Mydriatic (tropicamide 0.5%) — 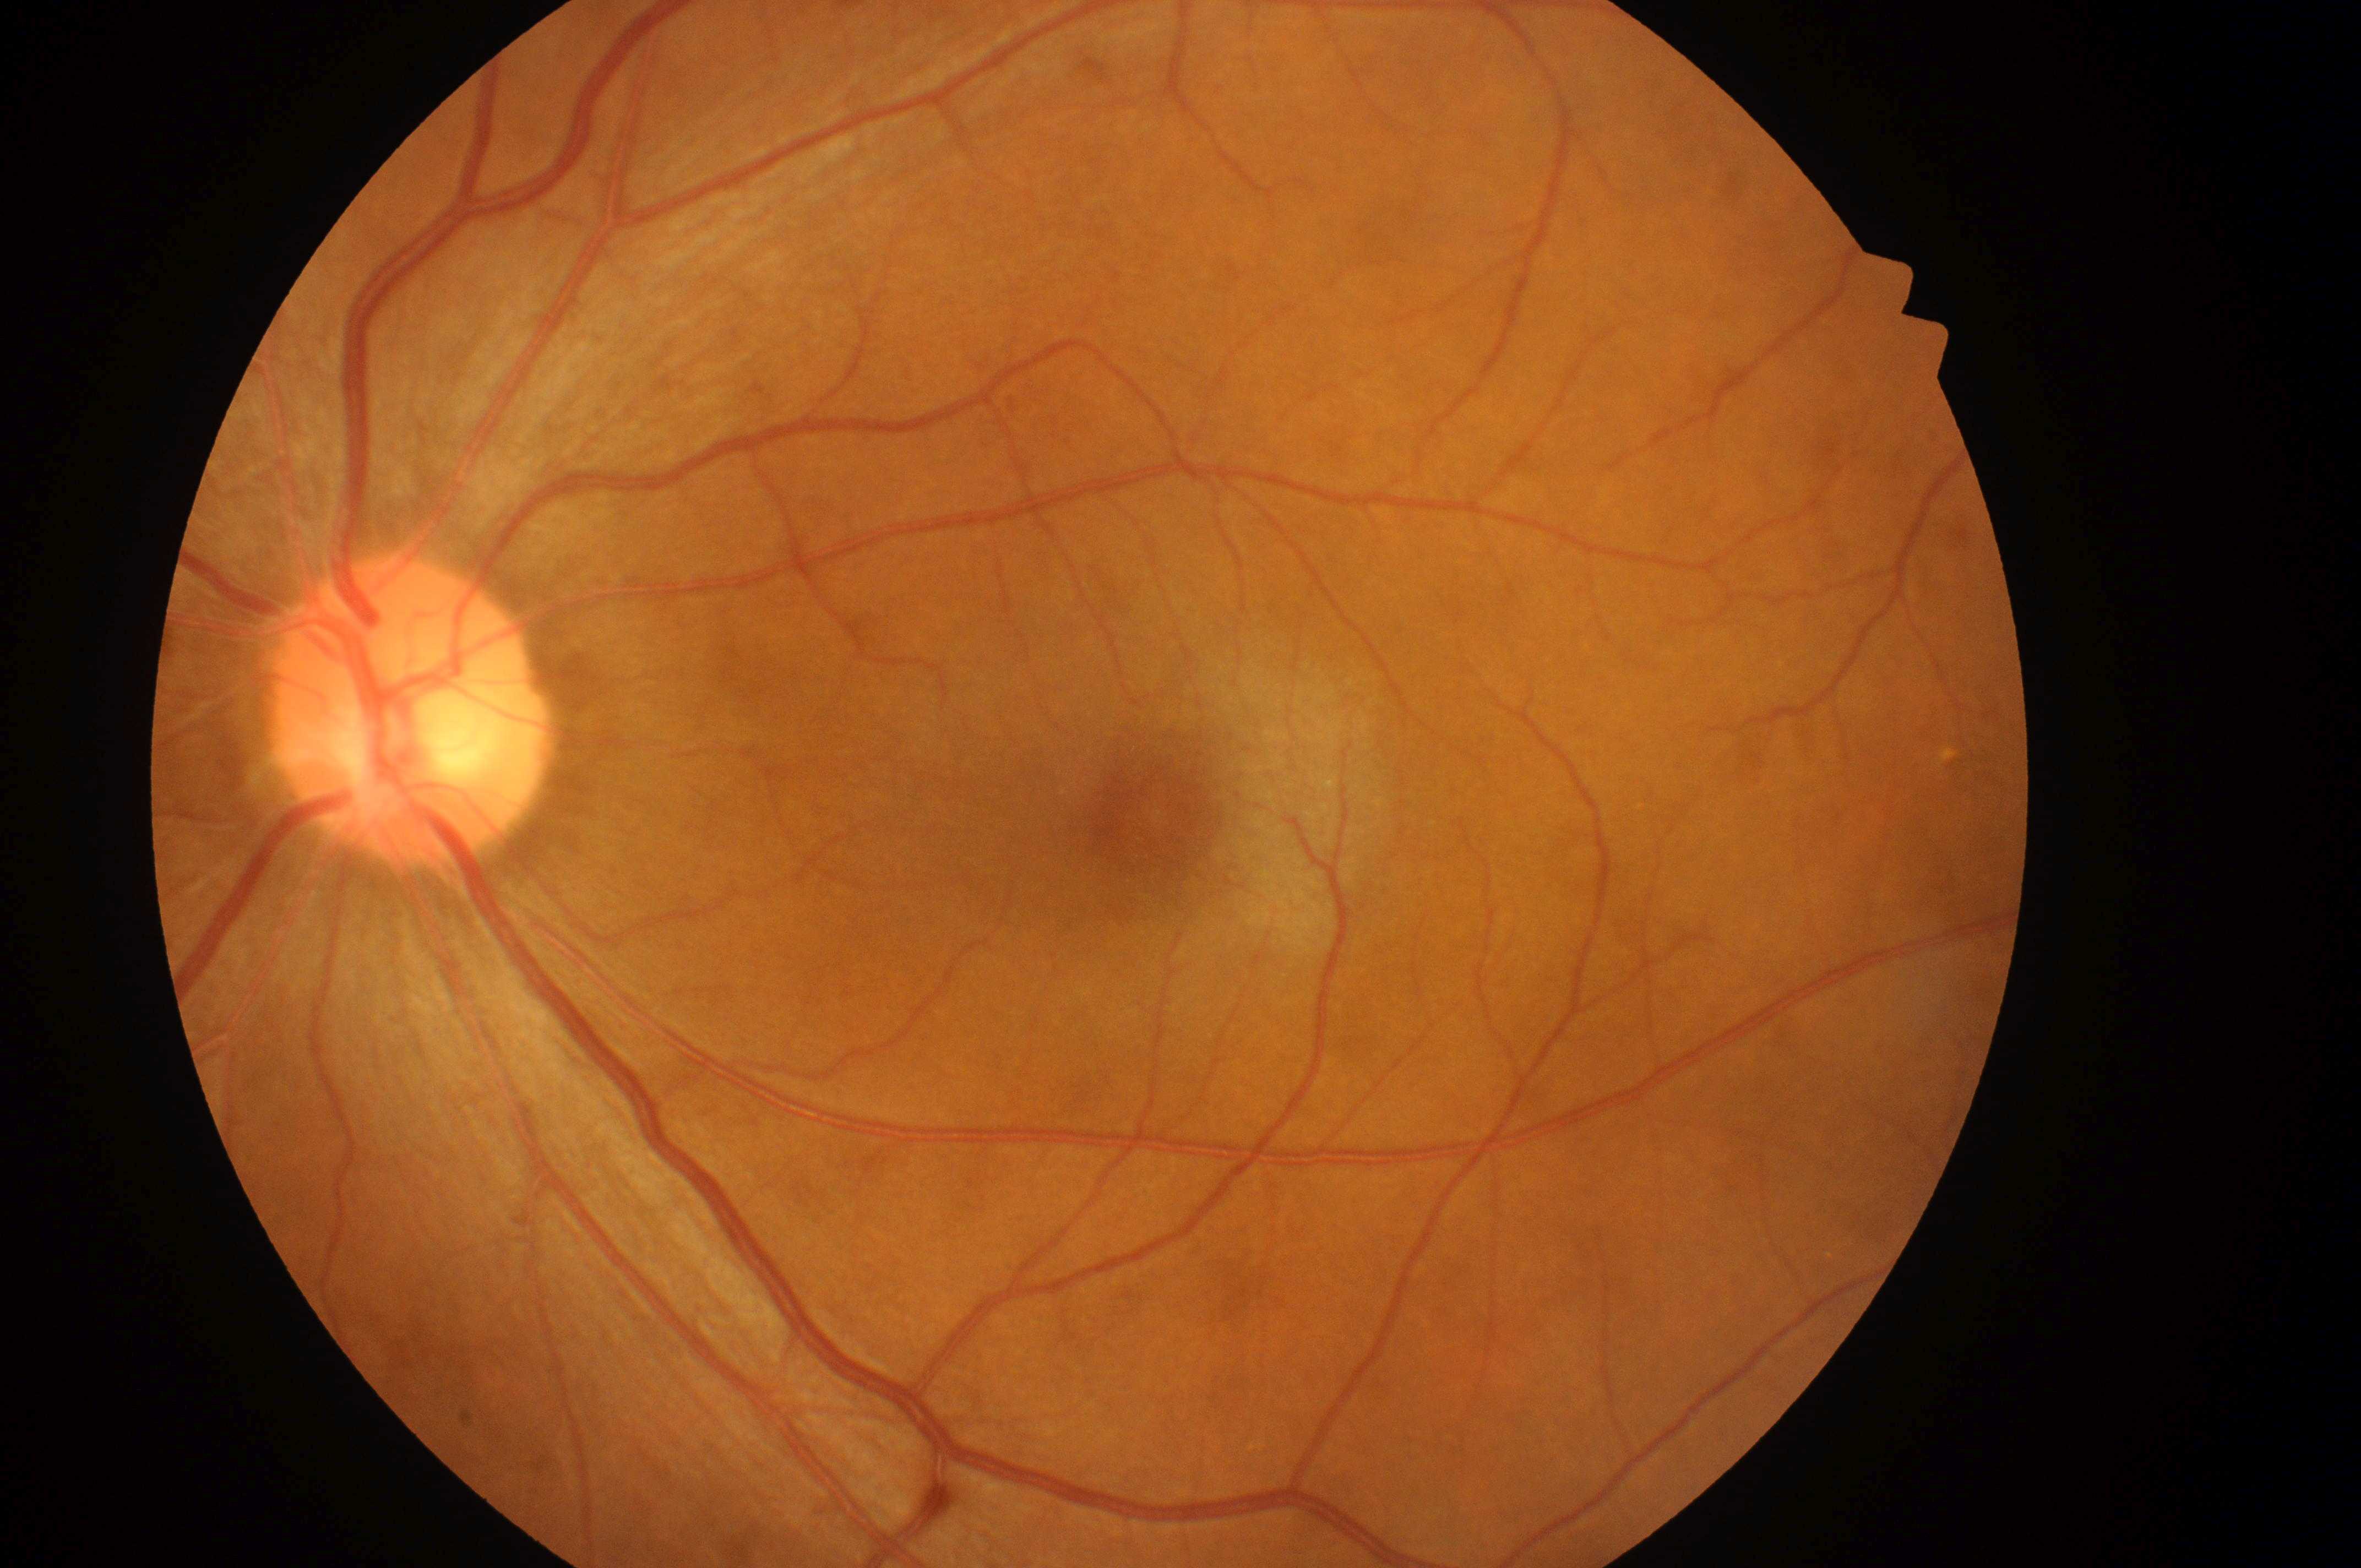
Q: What is the DME risk grade?
A: grade 0 (no risk)
Q: Diabetic retinopathy severity?
A: 1 (mild NPDR)
Q: Fovea center?
A: x=1151, y=818
Q: What is the laterality?
A: oculus sinister
Q: Where is the optic disc?
A: x=400, y=721